45° FOV
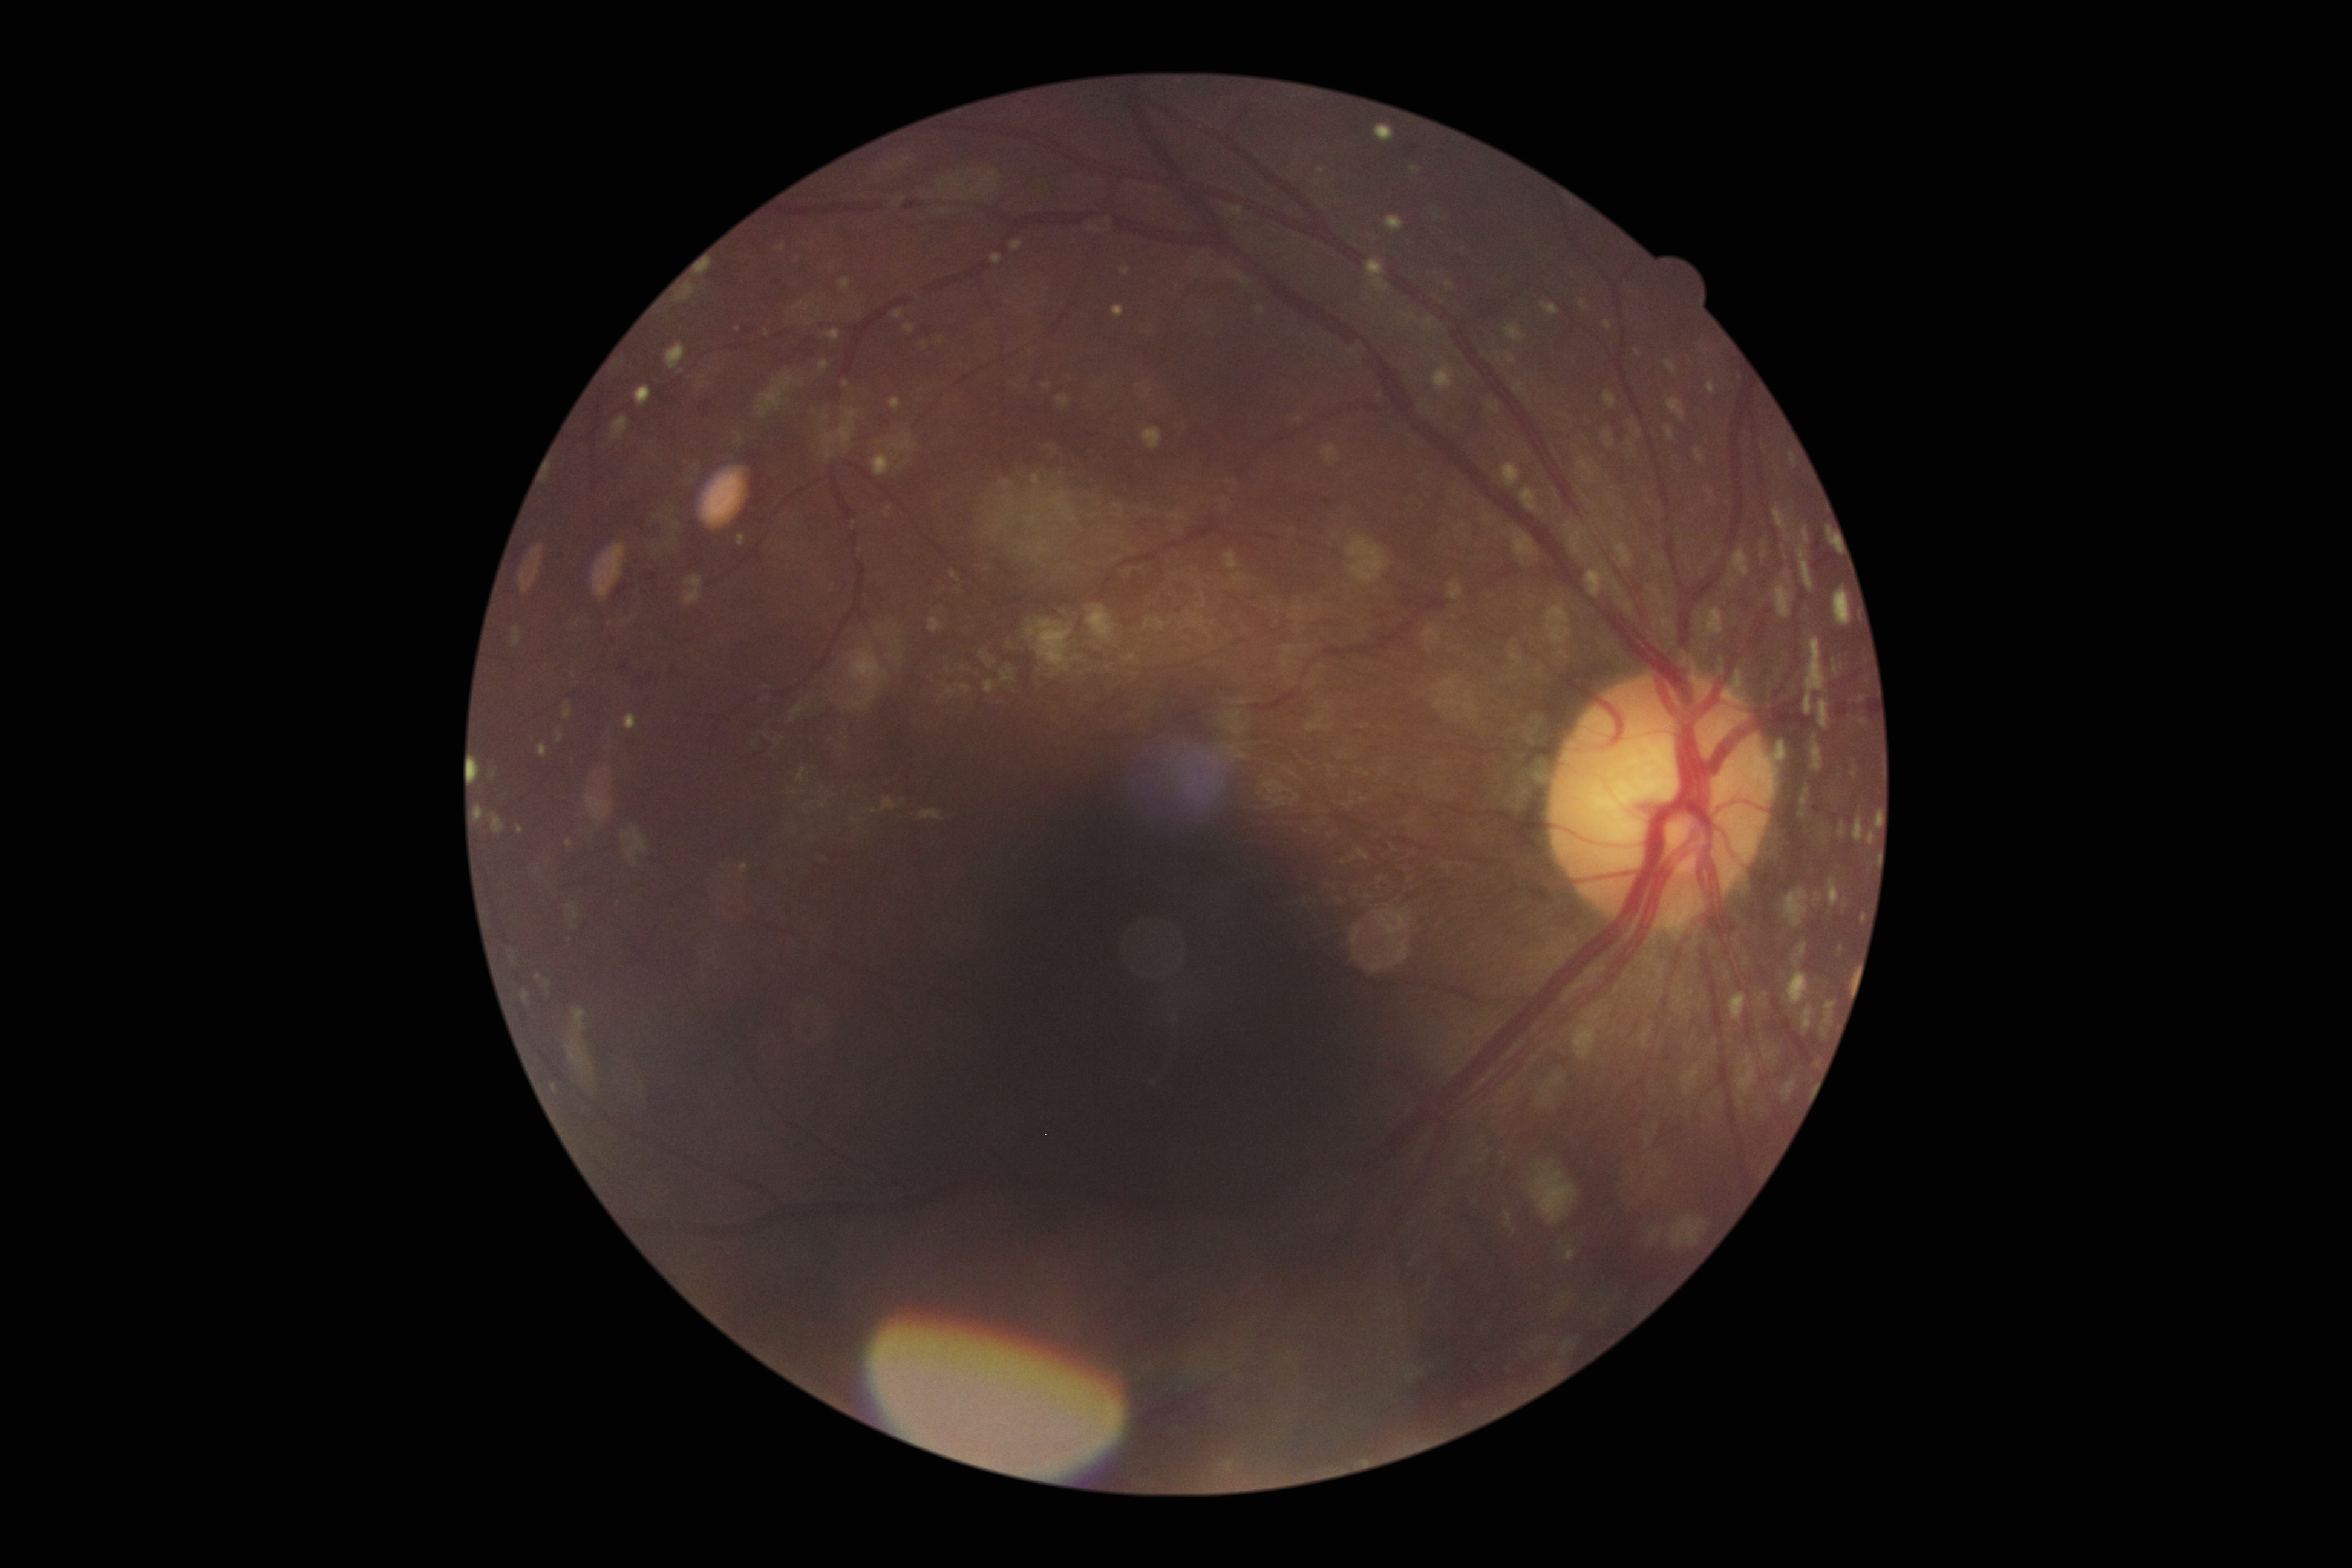

  dr_grade: grade 2